No pharmacologic dilation. Posterior pole color fundus photograph.
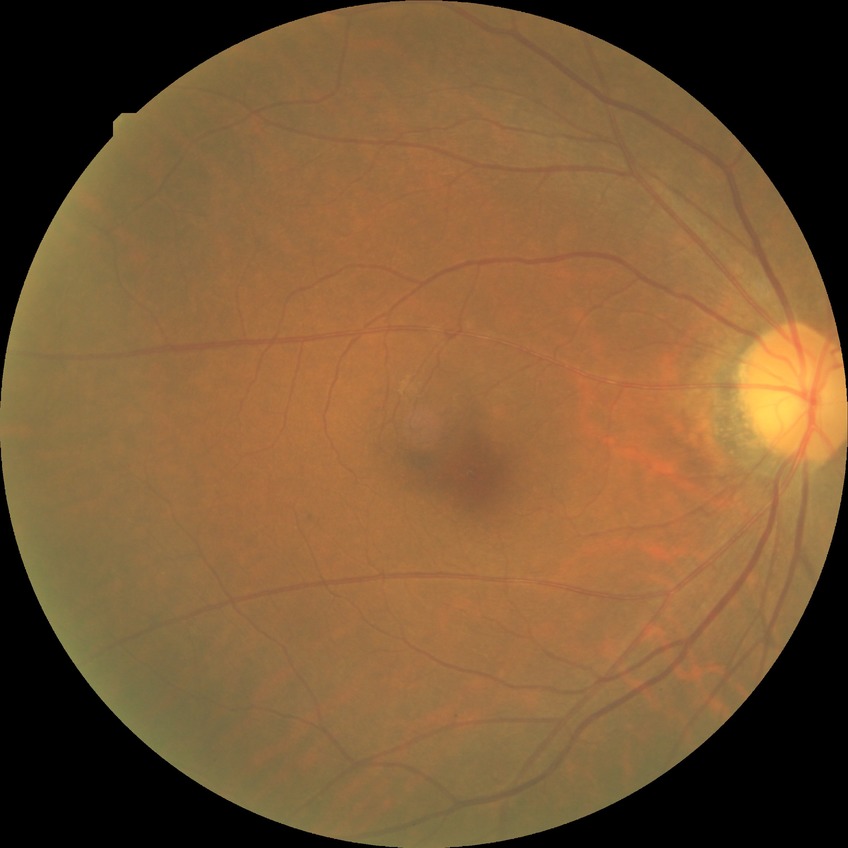
DR severity is NDR.
No signs of diabetic retinopathy.